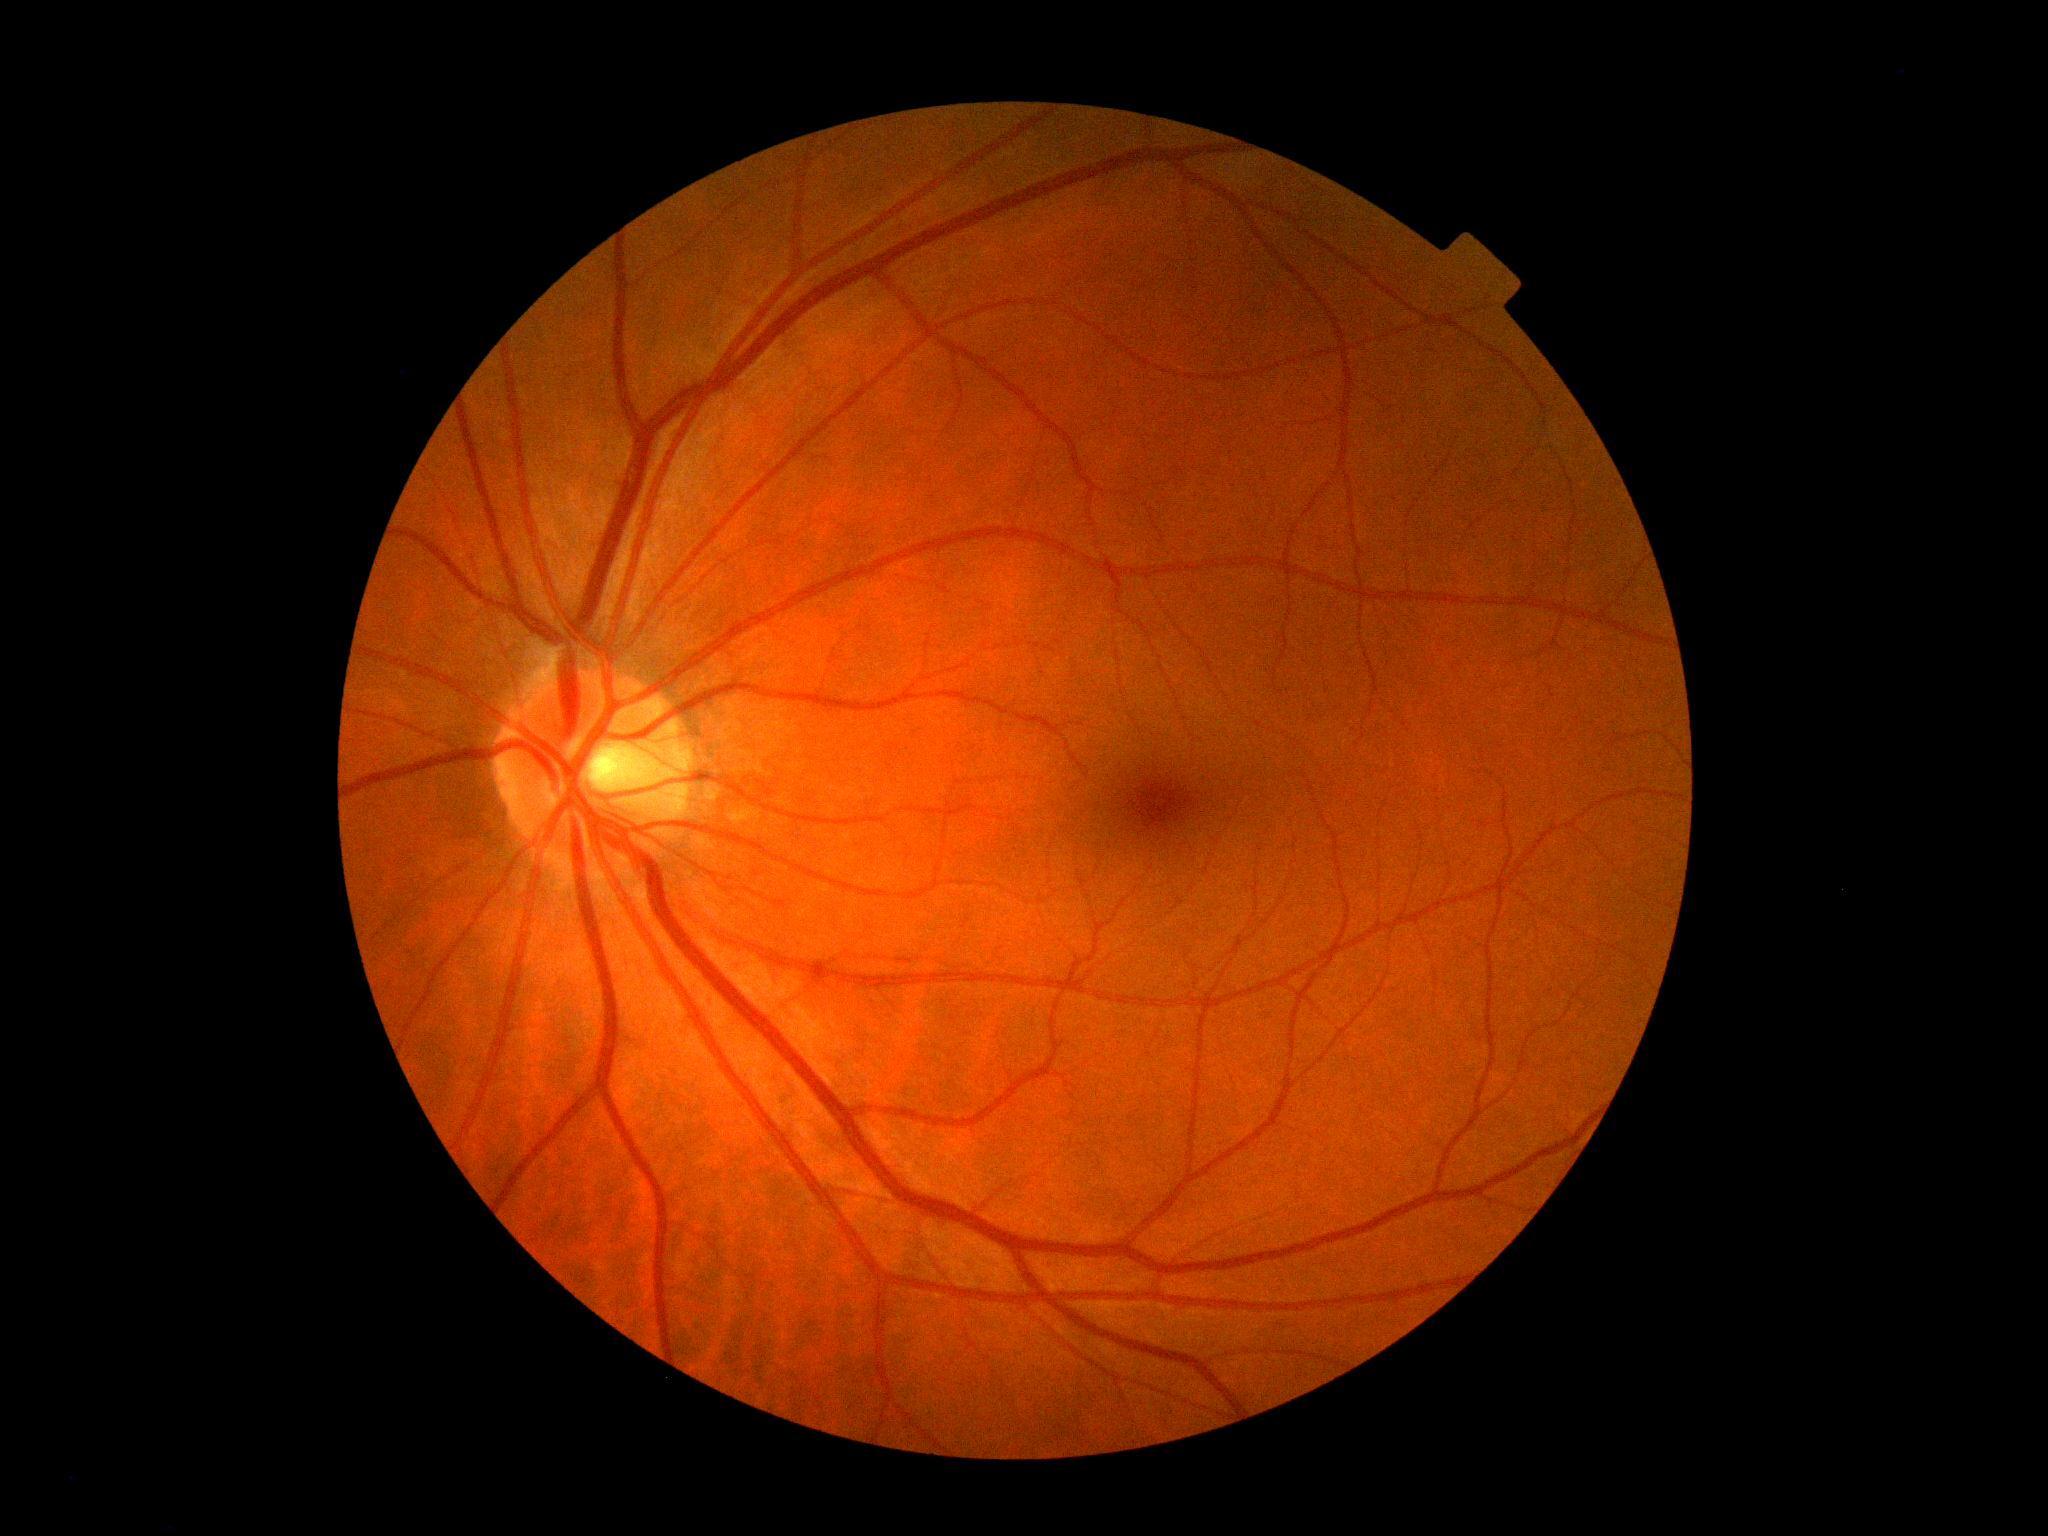

diabetic retinopathy severity=grade 0 — no visible signs of diabetic retinopathy.